Nonmydriatic fundus photograph. Acquired with a NIDEK AFC-230 — 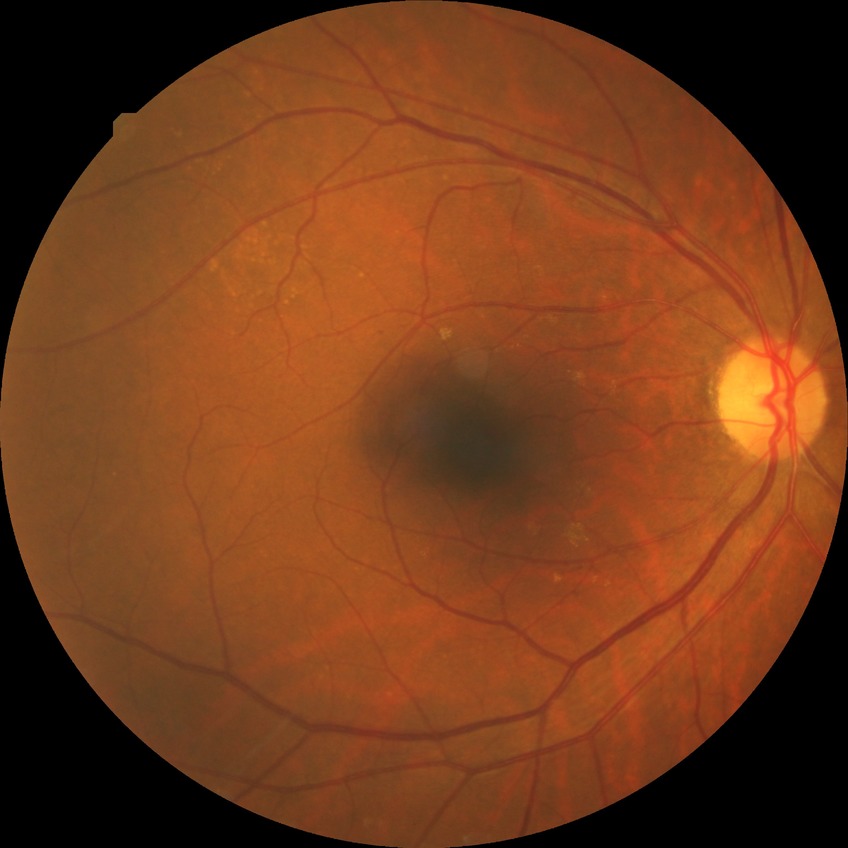 Retinopathy grade: simple diabetic retinopathy. DR class: non-proliferative diabetic retinopathy.